Camera: Phoenix ICON (100° FOV); Phoenix ICON wide-field infant fundus image: 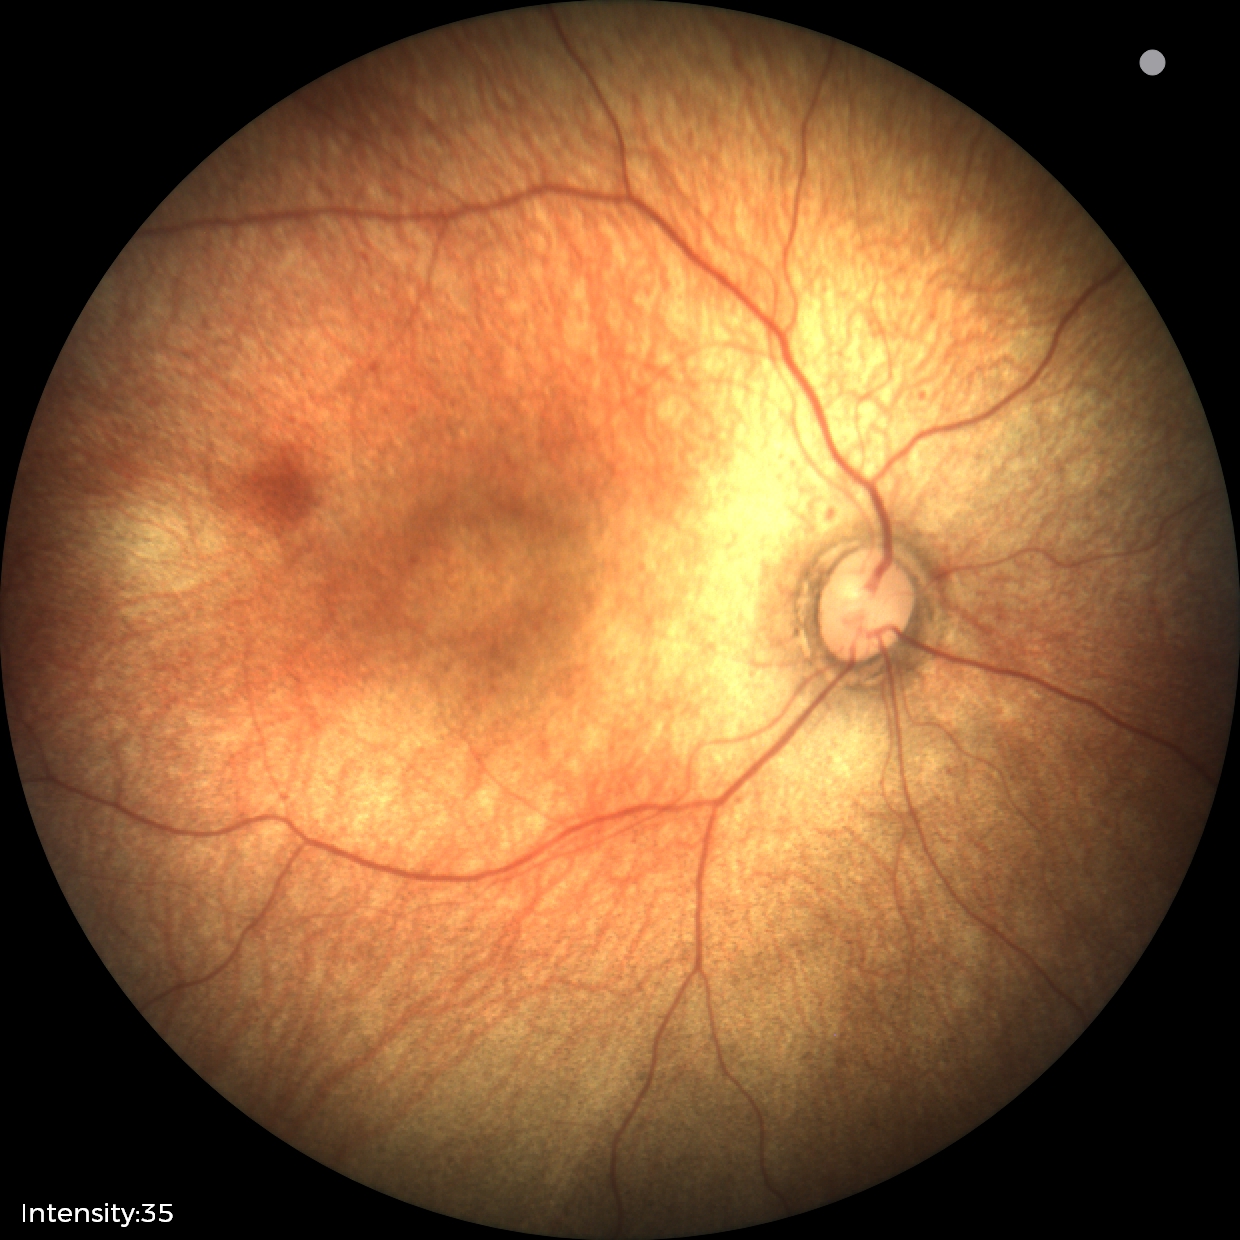
Screening diagnosis: physiological appearance.